848 x 848 pixels: 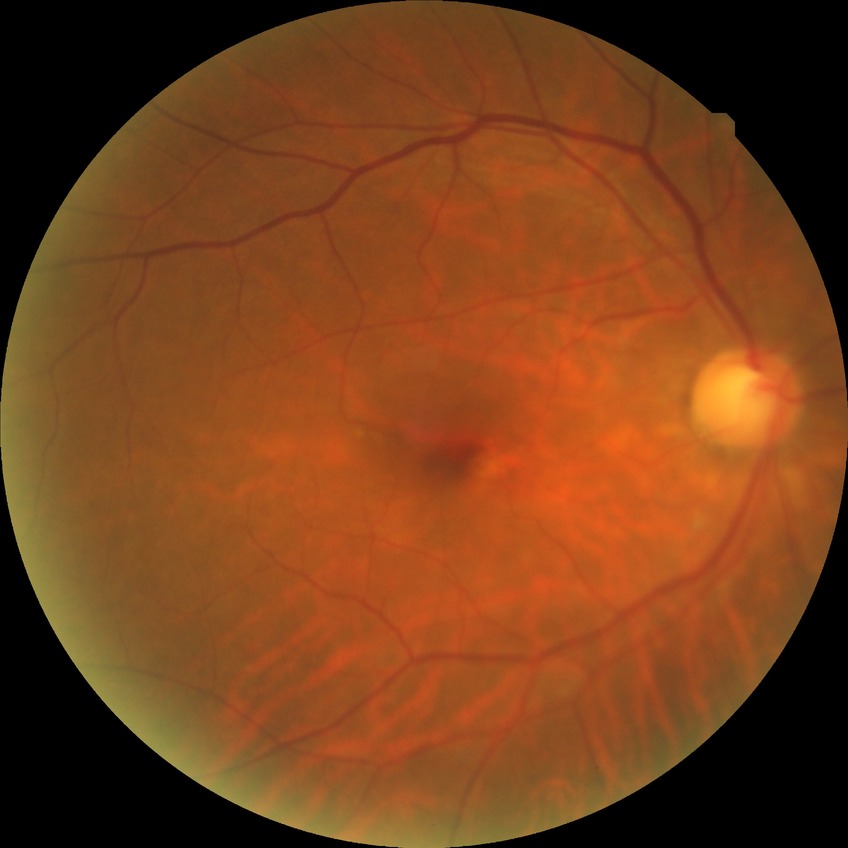 Diabetic retinopathy (DR): NDR (no diabetic retinopathy).